45° FOV.
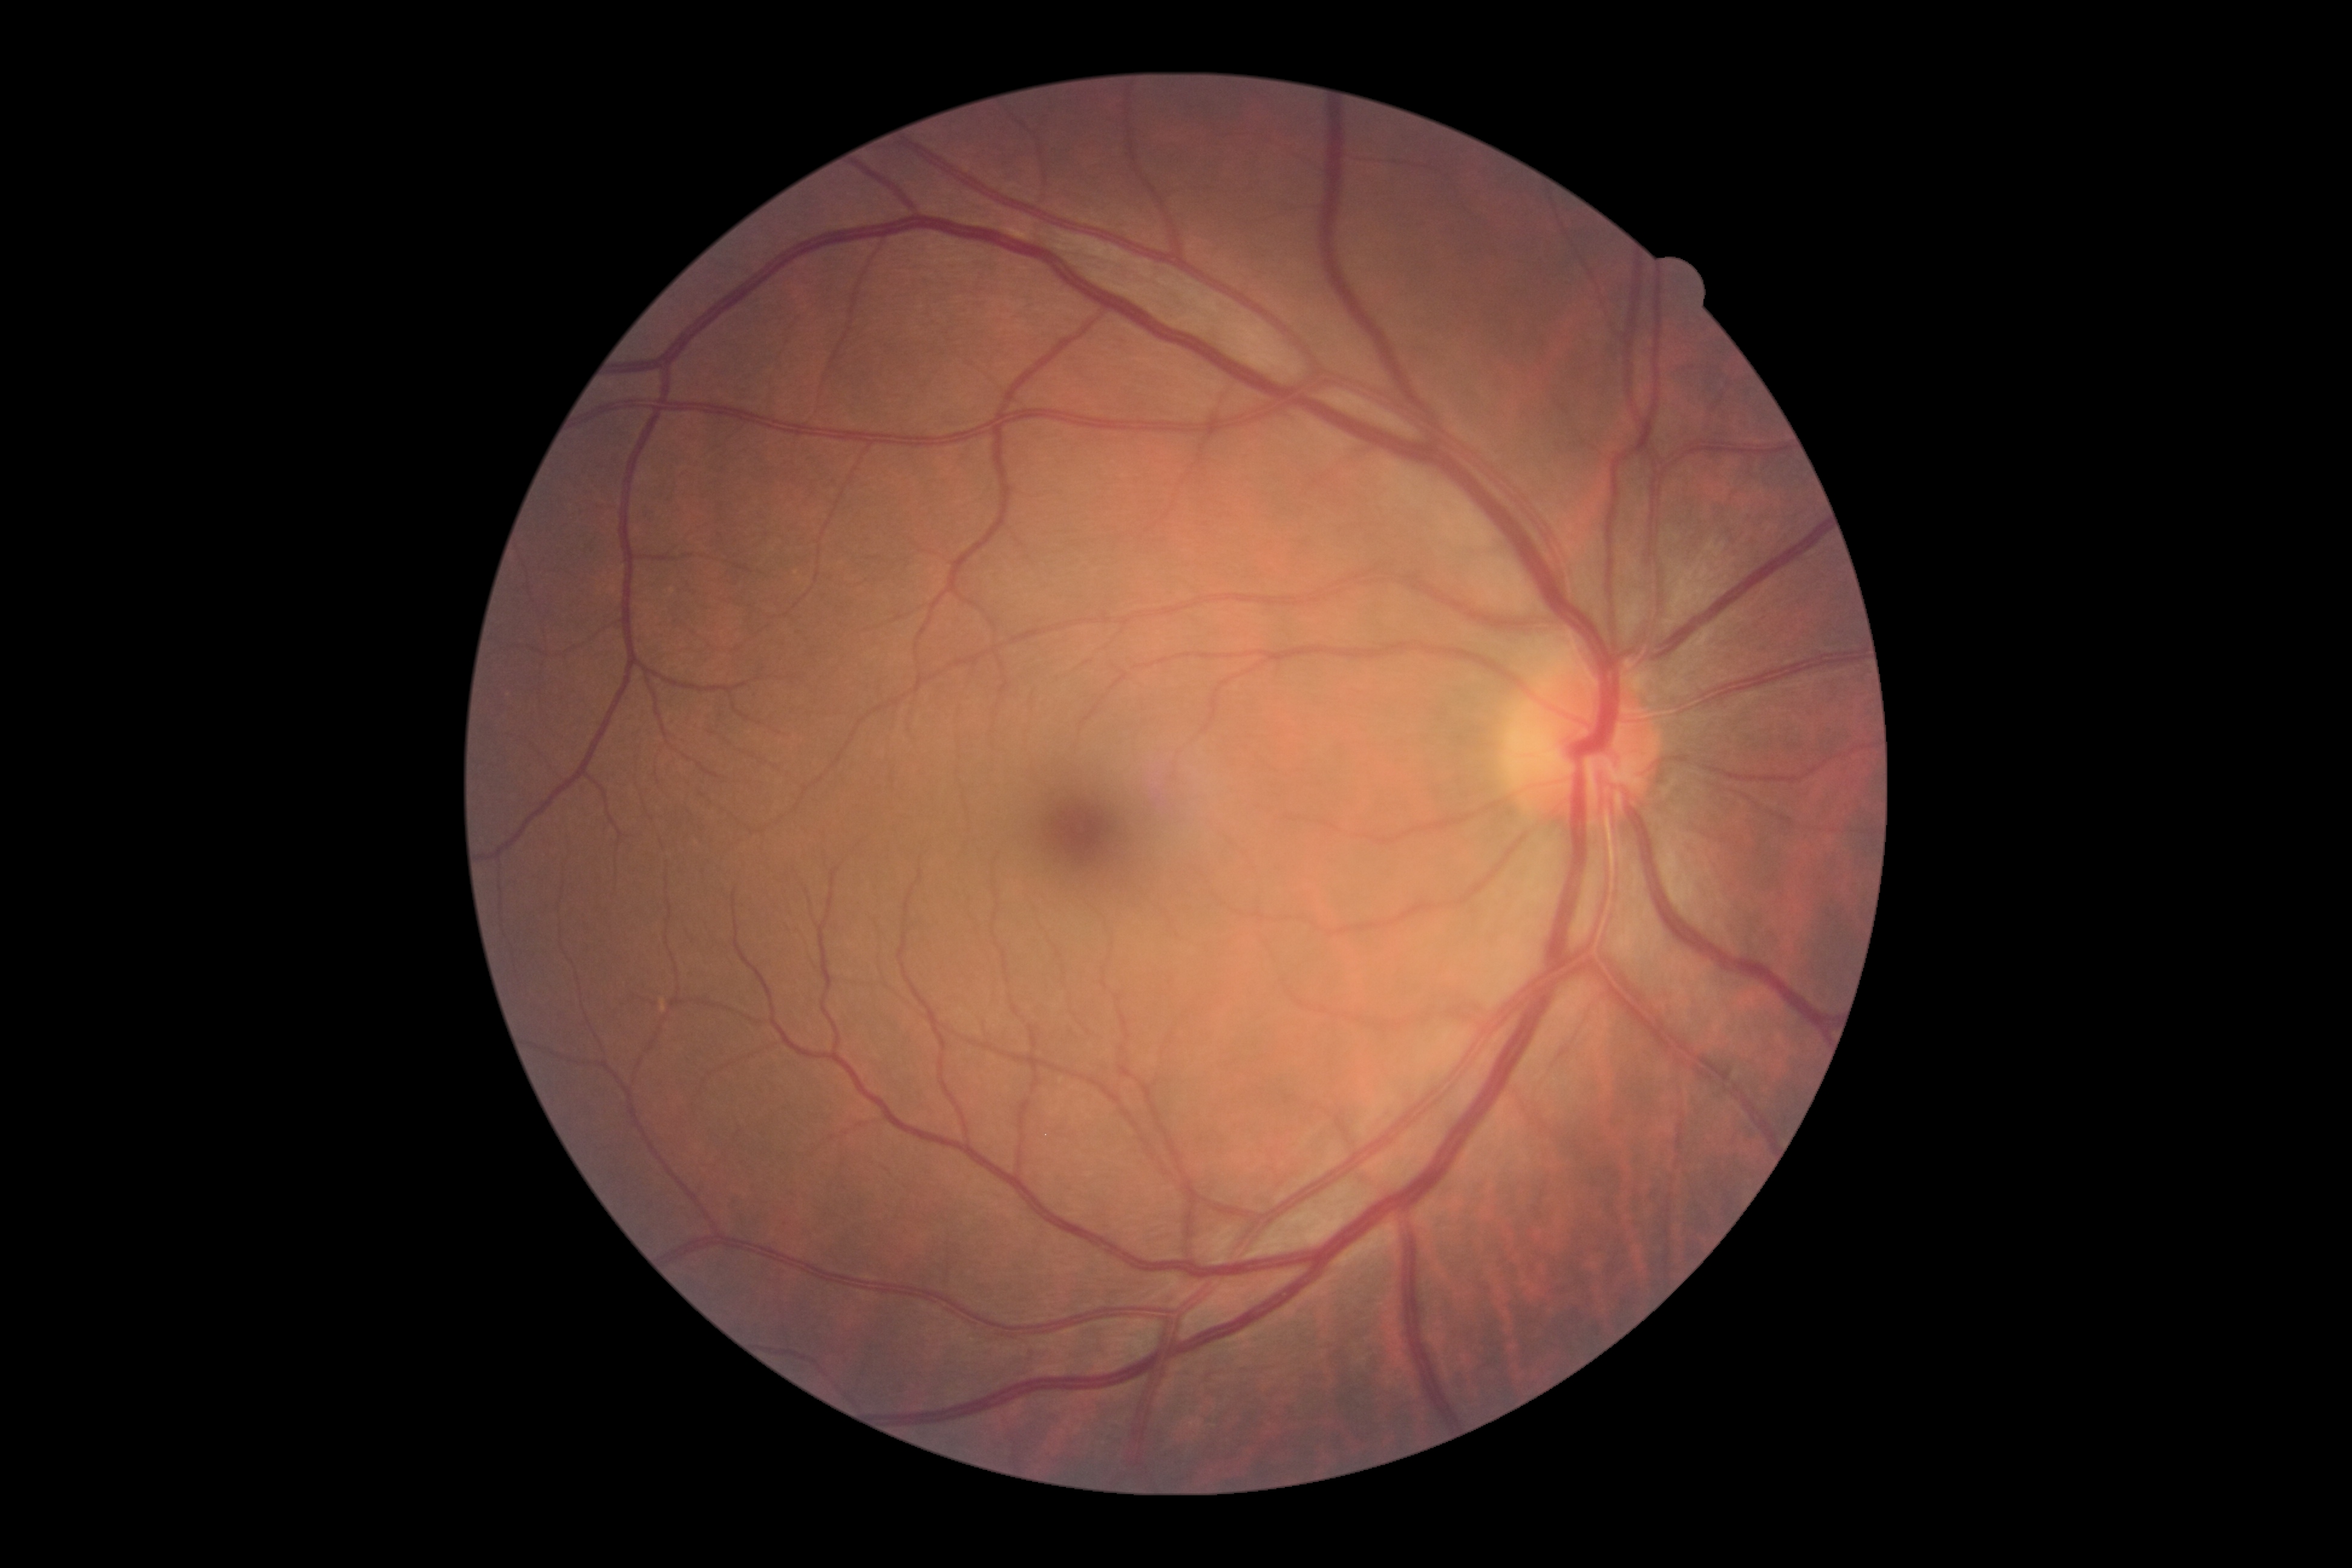
Findings:
• DR: no apparent diabetic retinopathy (grade 0)